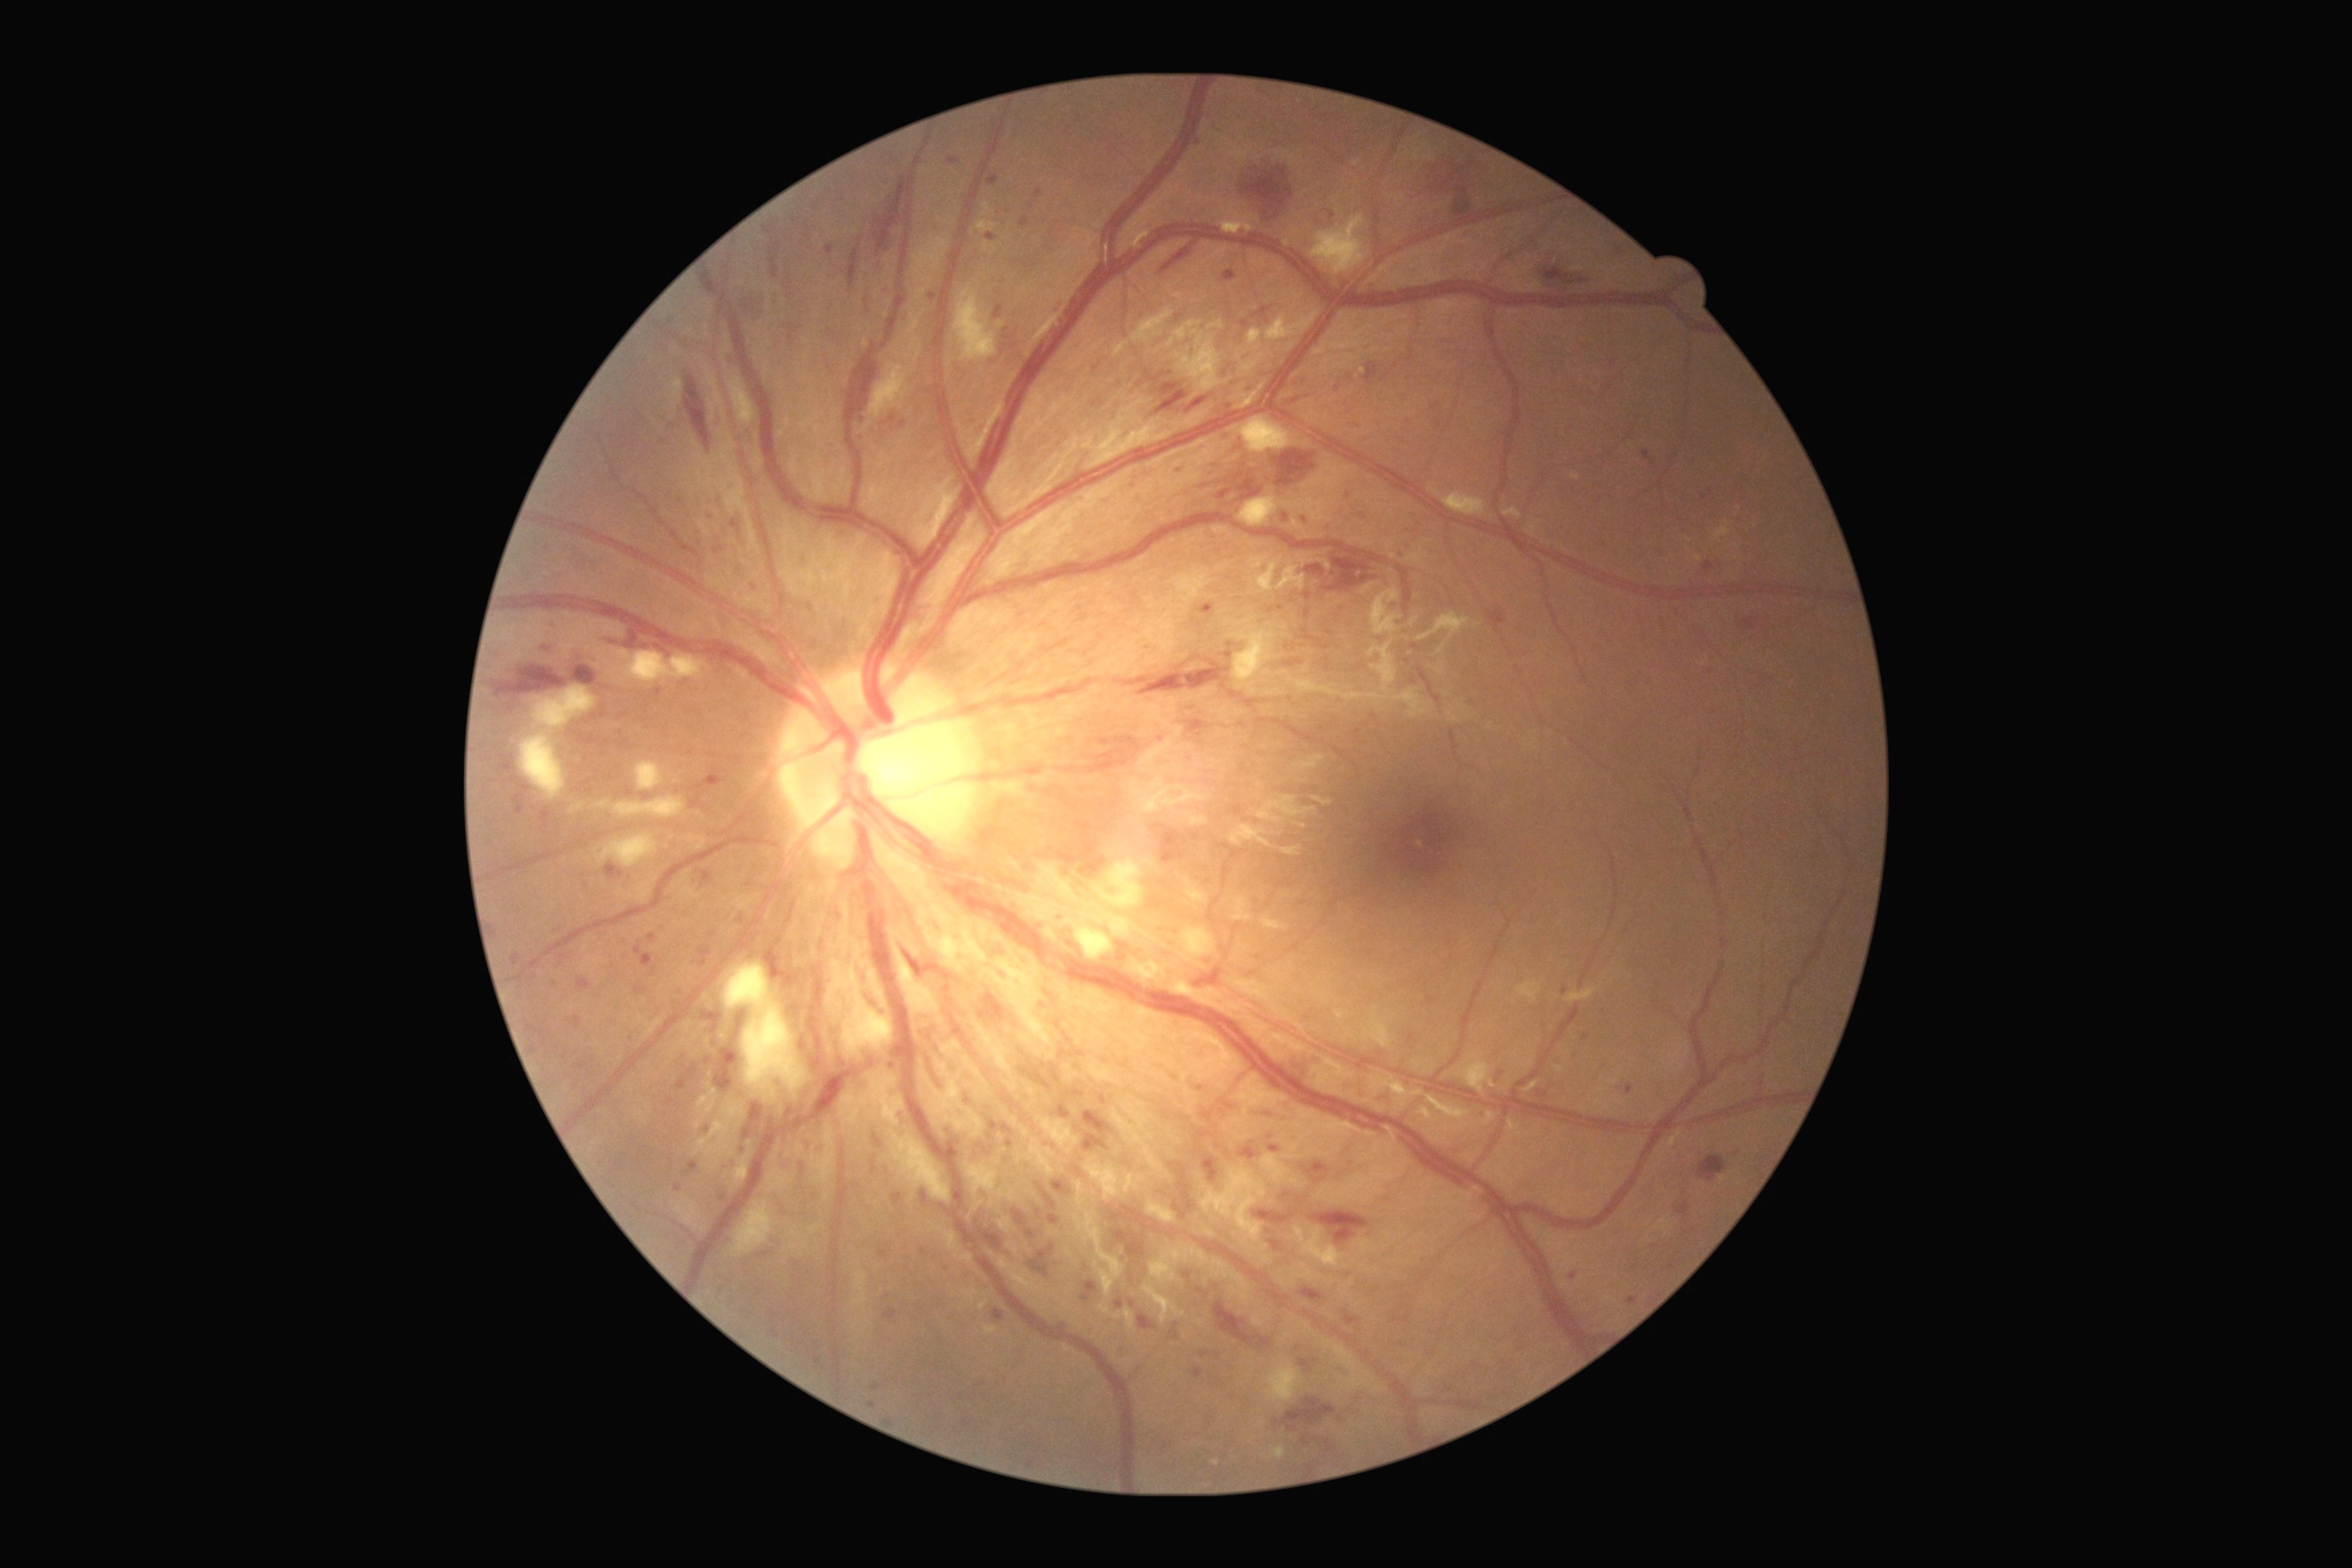 {"partial": true, "dr_grade": 3, "lesions": {"ma": [[1084, 1112, 1112, 1152], [977, 1190, 992, 1200], [1703, 562, 1714, 574], [799, 1039, 808, 1052], [1204, 1159, 1219, 1182], [649, 934, 656, 945], [827, 246, 834, 255], [576, 977, 591, 992], [1496, 1070, 1505, 1081]], "ma_small_centers": [[1449, 1389], [741, 919], [813, 608], [587, 886], [1565, 992], [1286, 1197], [754, 588], [1704, 497], [1133, 1304], [807, 1144]], "se": [[1239, 495, 1331, 527], [1248, 329, 1262, 351], [1266, 309, 1320, 342], [1182, 877, 1210, 905], [1171, 981, 1224, 1008], [1182, 928, 1217, 963], [972, 1017, 1019, 1093], [1271, 1446, 1286, 1460], [925, 923, 988, 974], [1166, 322, 1222, 393], [591, 796, 687, 819], [981, 936, 1055, 1048], [1237, 351, 1248, 362], [1063, 921, 1072, 925], [1093, 859, 1146, 910], [1242, 353, 1266, 375]], "se_small_centers": [[1148, 936], [964, 1000], [1189, 349]], "he": [[1259, 718, 1282, 723], [1295, 1052, 1322, 1075], [1289, 397, 1308, 406], [769, 244, 779, 279], [1161, 384, 1179, 397], [495, 665, 569, 698], [1313, 1211, 1369, 1244], [1268, 1389, 1340, 1469], [1139, 663, 1230, 696], [1700, 1155, 1727, 1182], [1030, 1244, 1055, 1279], [856, 358, 883, 411], [730, 286, 763, 322], [1349, 424, 1362, 429], [571, 665, 598, 687]], "he_small_centers": [[552, 628]]}}